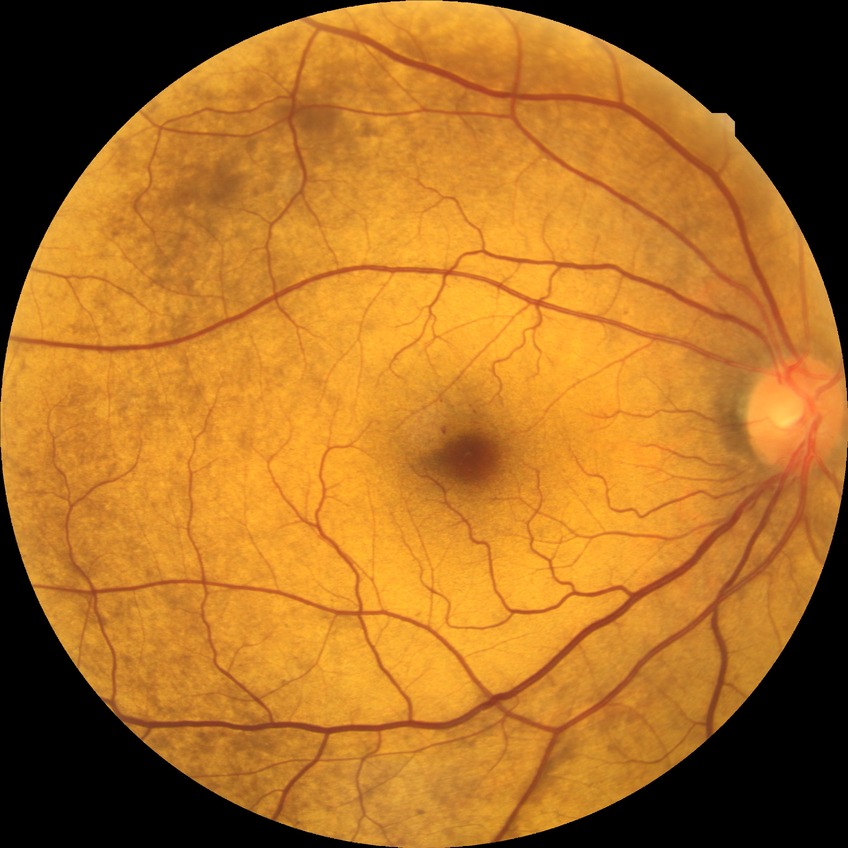

{"dr_impression": "no signs of DR", "davis_grade": "NDR"}